Retinal fundus photograph: 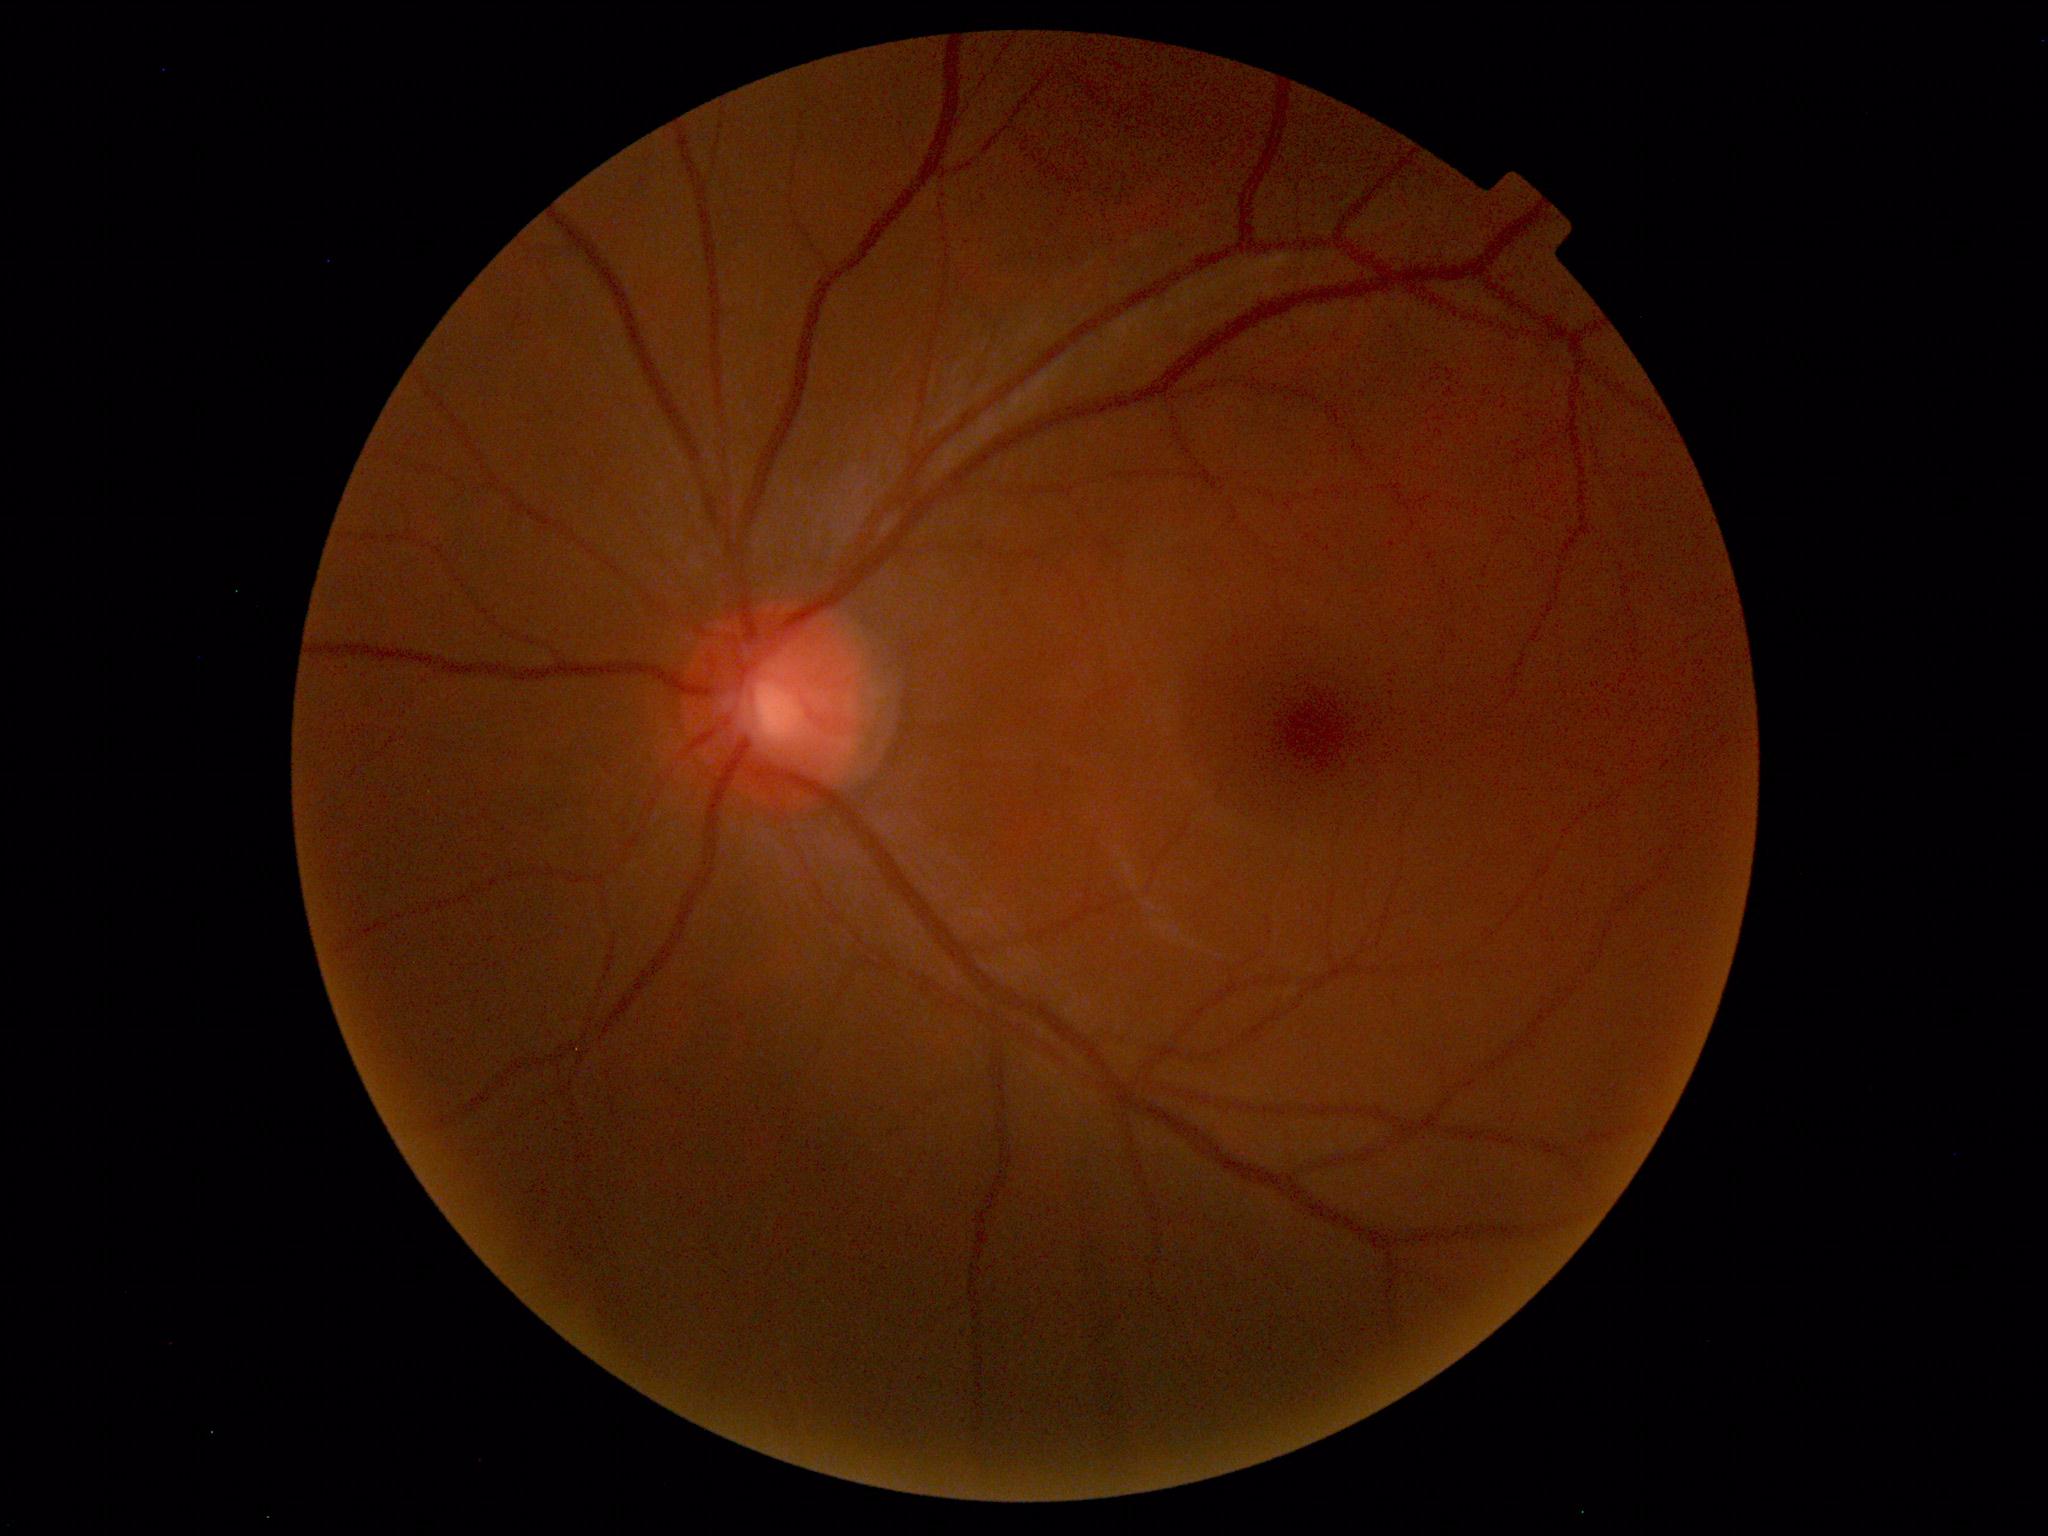 No abnormal findings on fundus examination.